Retinal fundus photograph
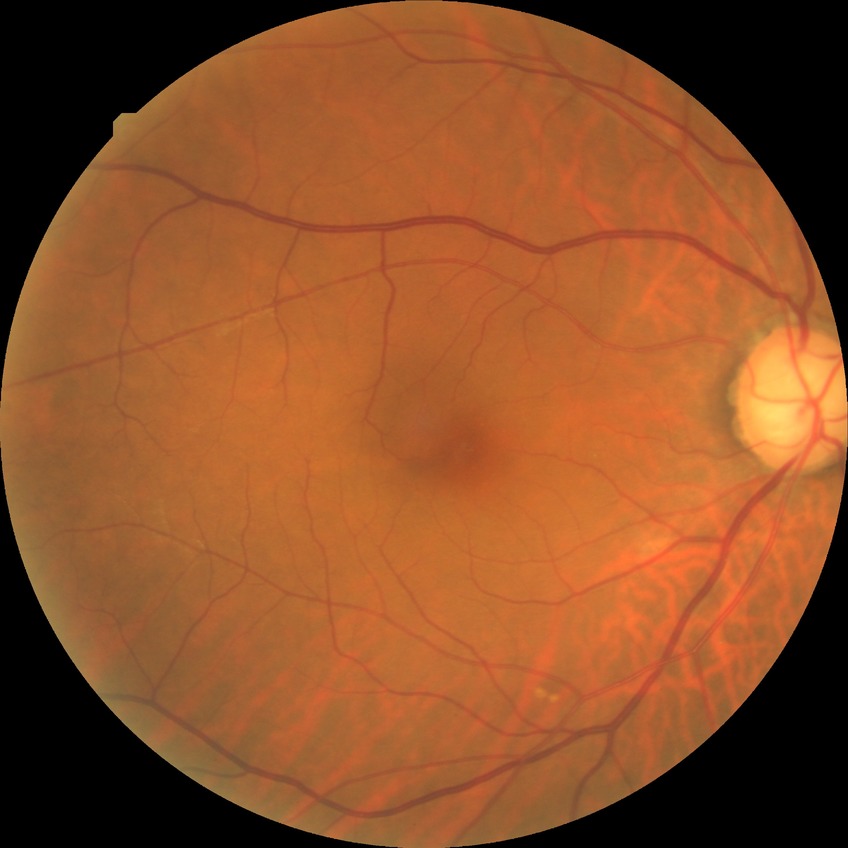 diabetic retinopathy (DR)=no diabetic retinopathy (NDR).